848x848px, color fundus photograph, DR severity per modified Davis staging, nonmydriatic fundus photograph:
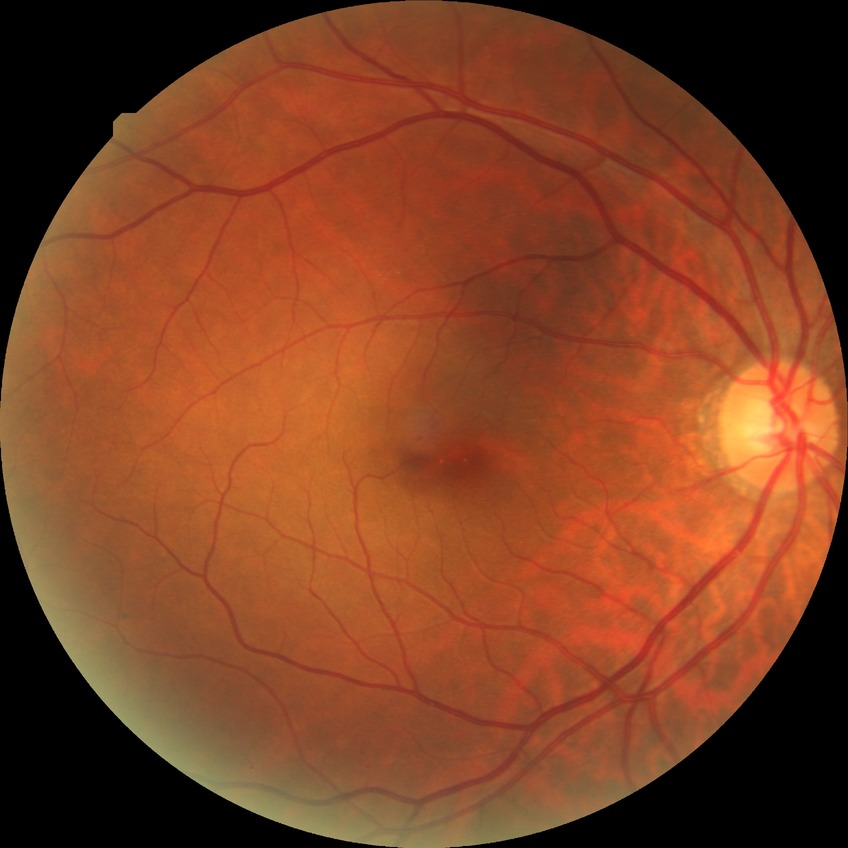 DR class=non-proliferative diabetic retinopathy; diabetic retinopathy (DR)=simple diabetic retinopathy (SDR).